Modified Davis classification — 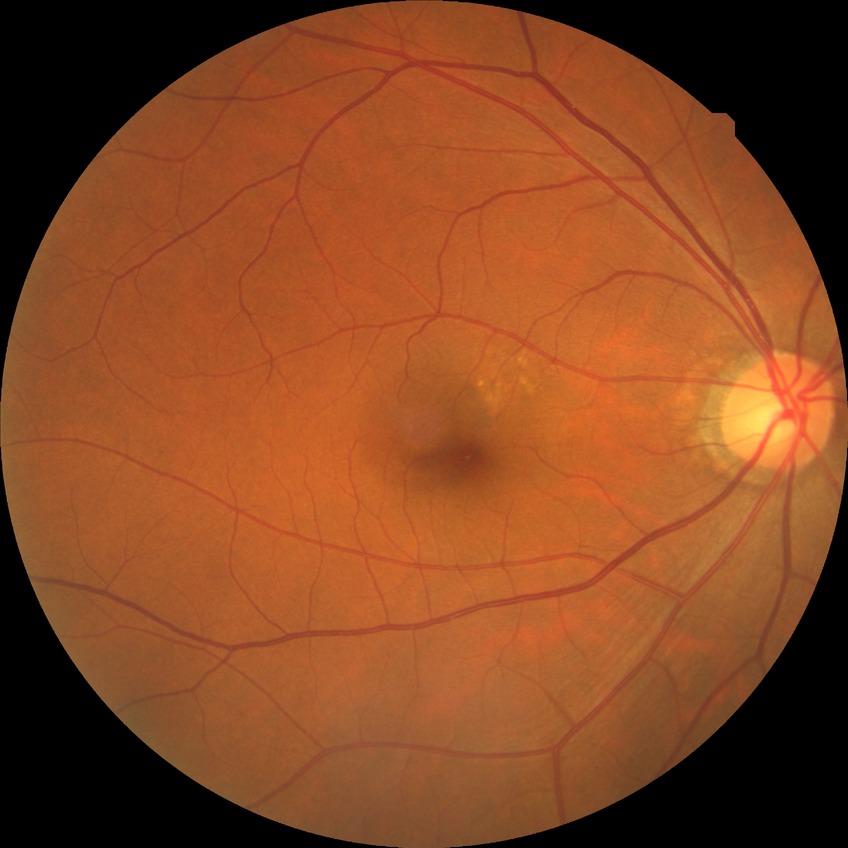 Diabetic retinopathy (DR): NDR (no diabetic retinopathy).